1240 x 1240 pixels · infant wide-field retinal image.
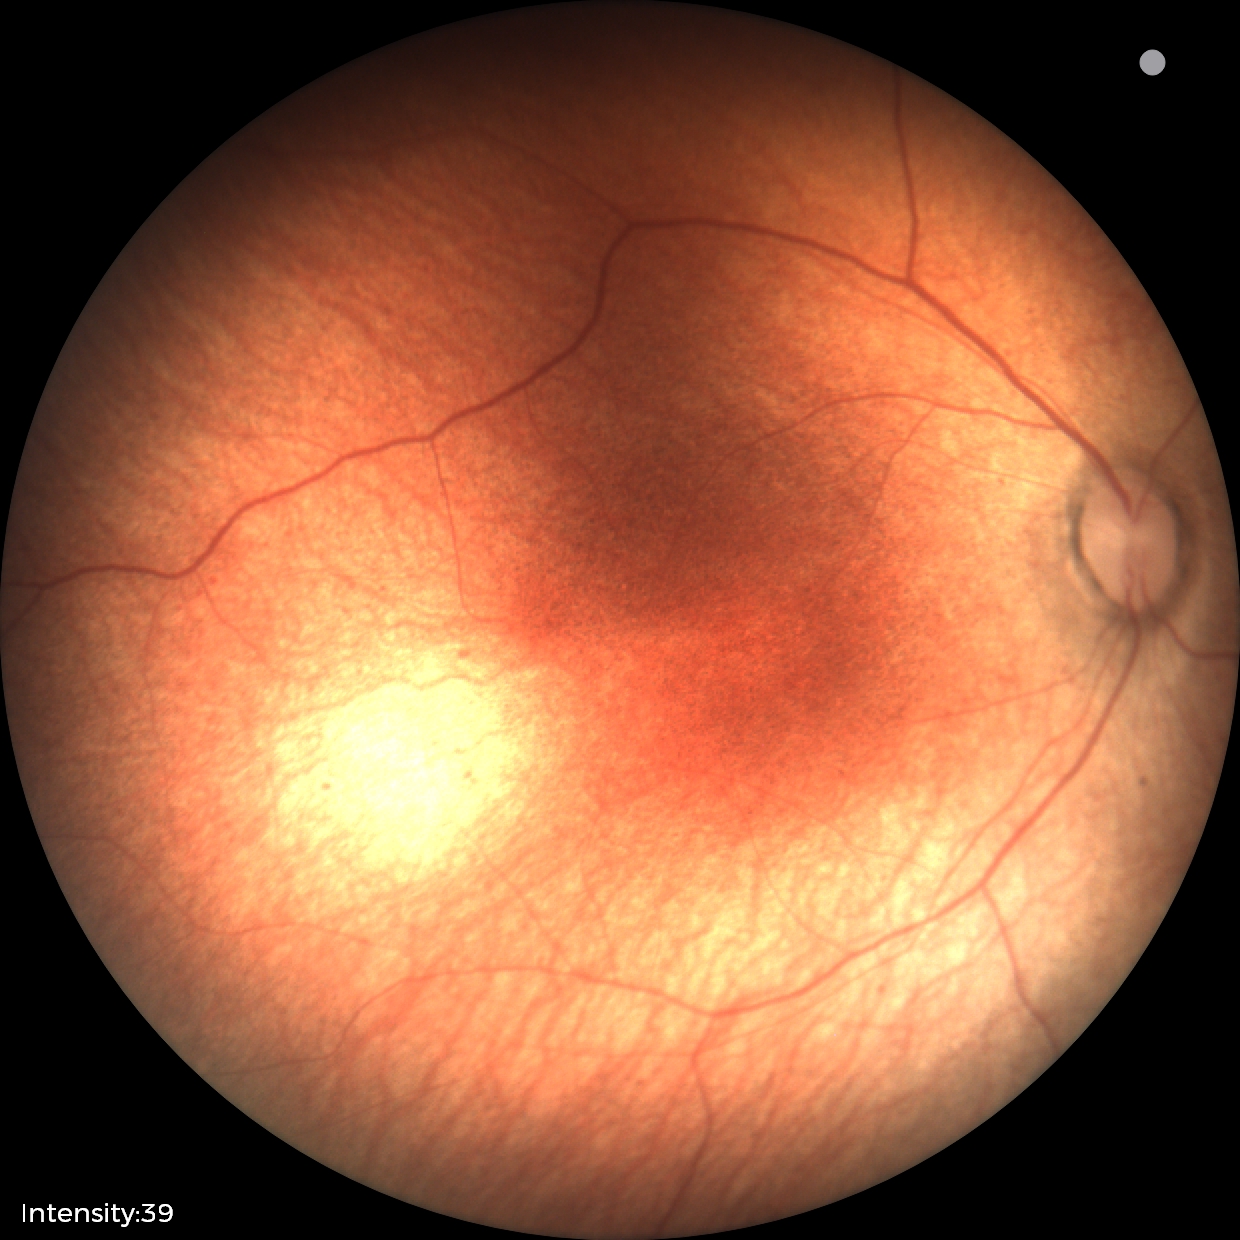 Q: What is the diagnosis from this examination?
A: no abnormal retinal findings